45° FOV; retinal fundus photograph — 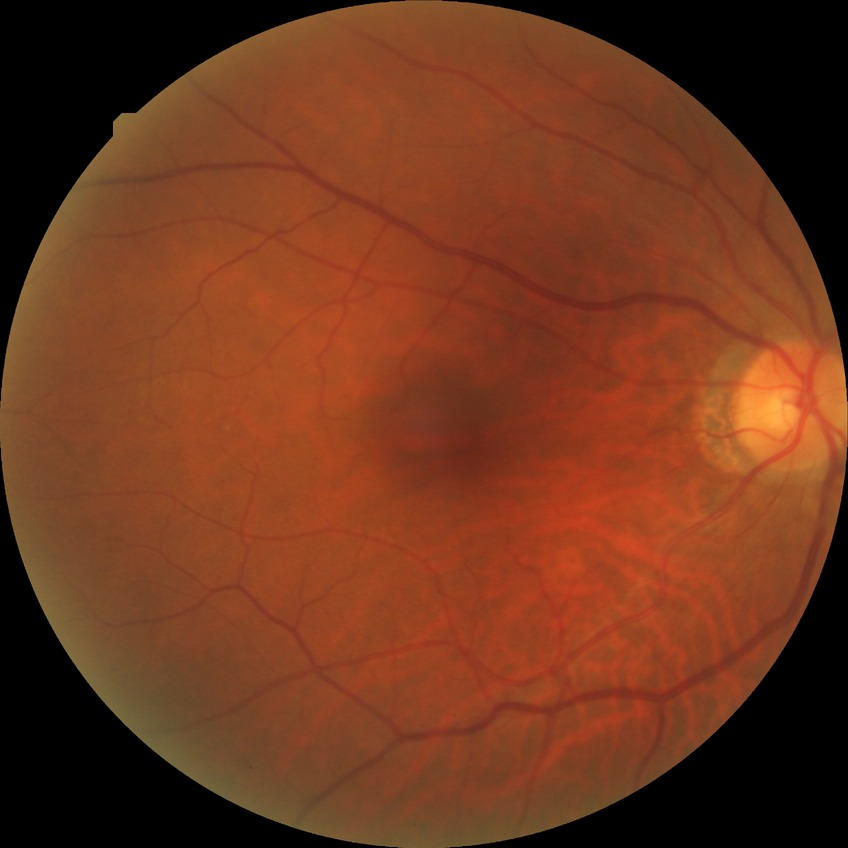

No signs of diabetic retinopathy.
Davis DR grade is NDR.